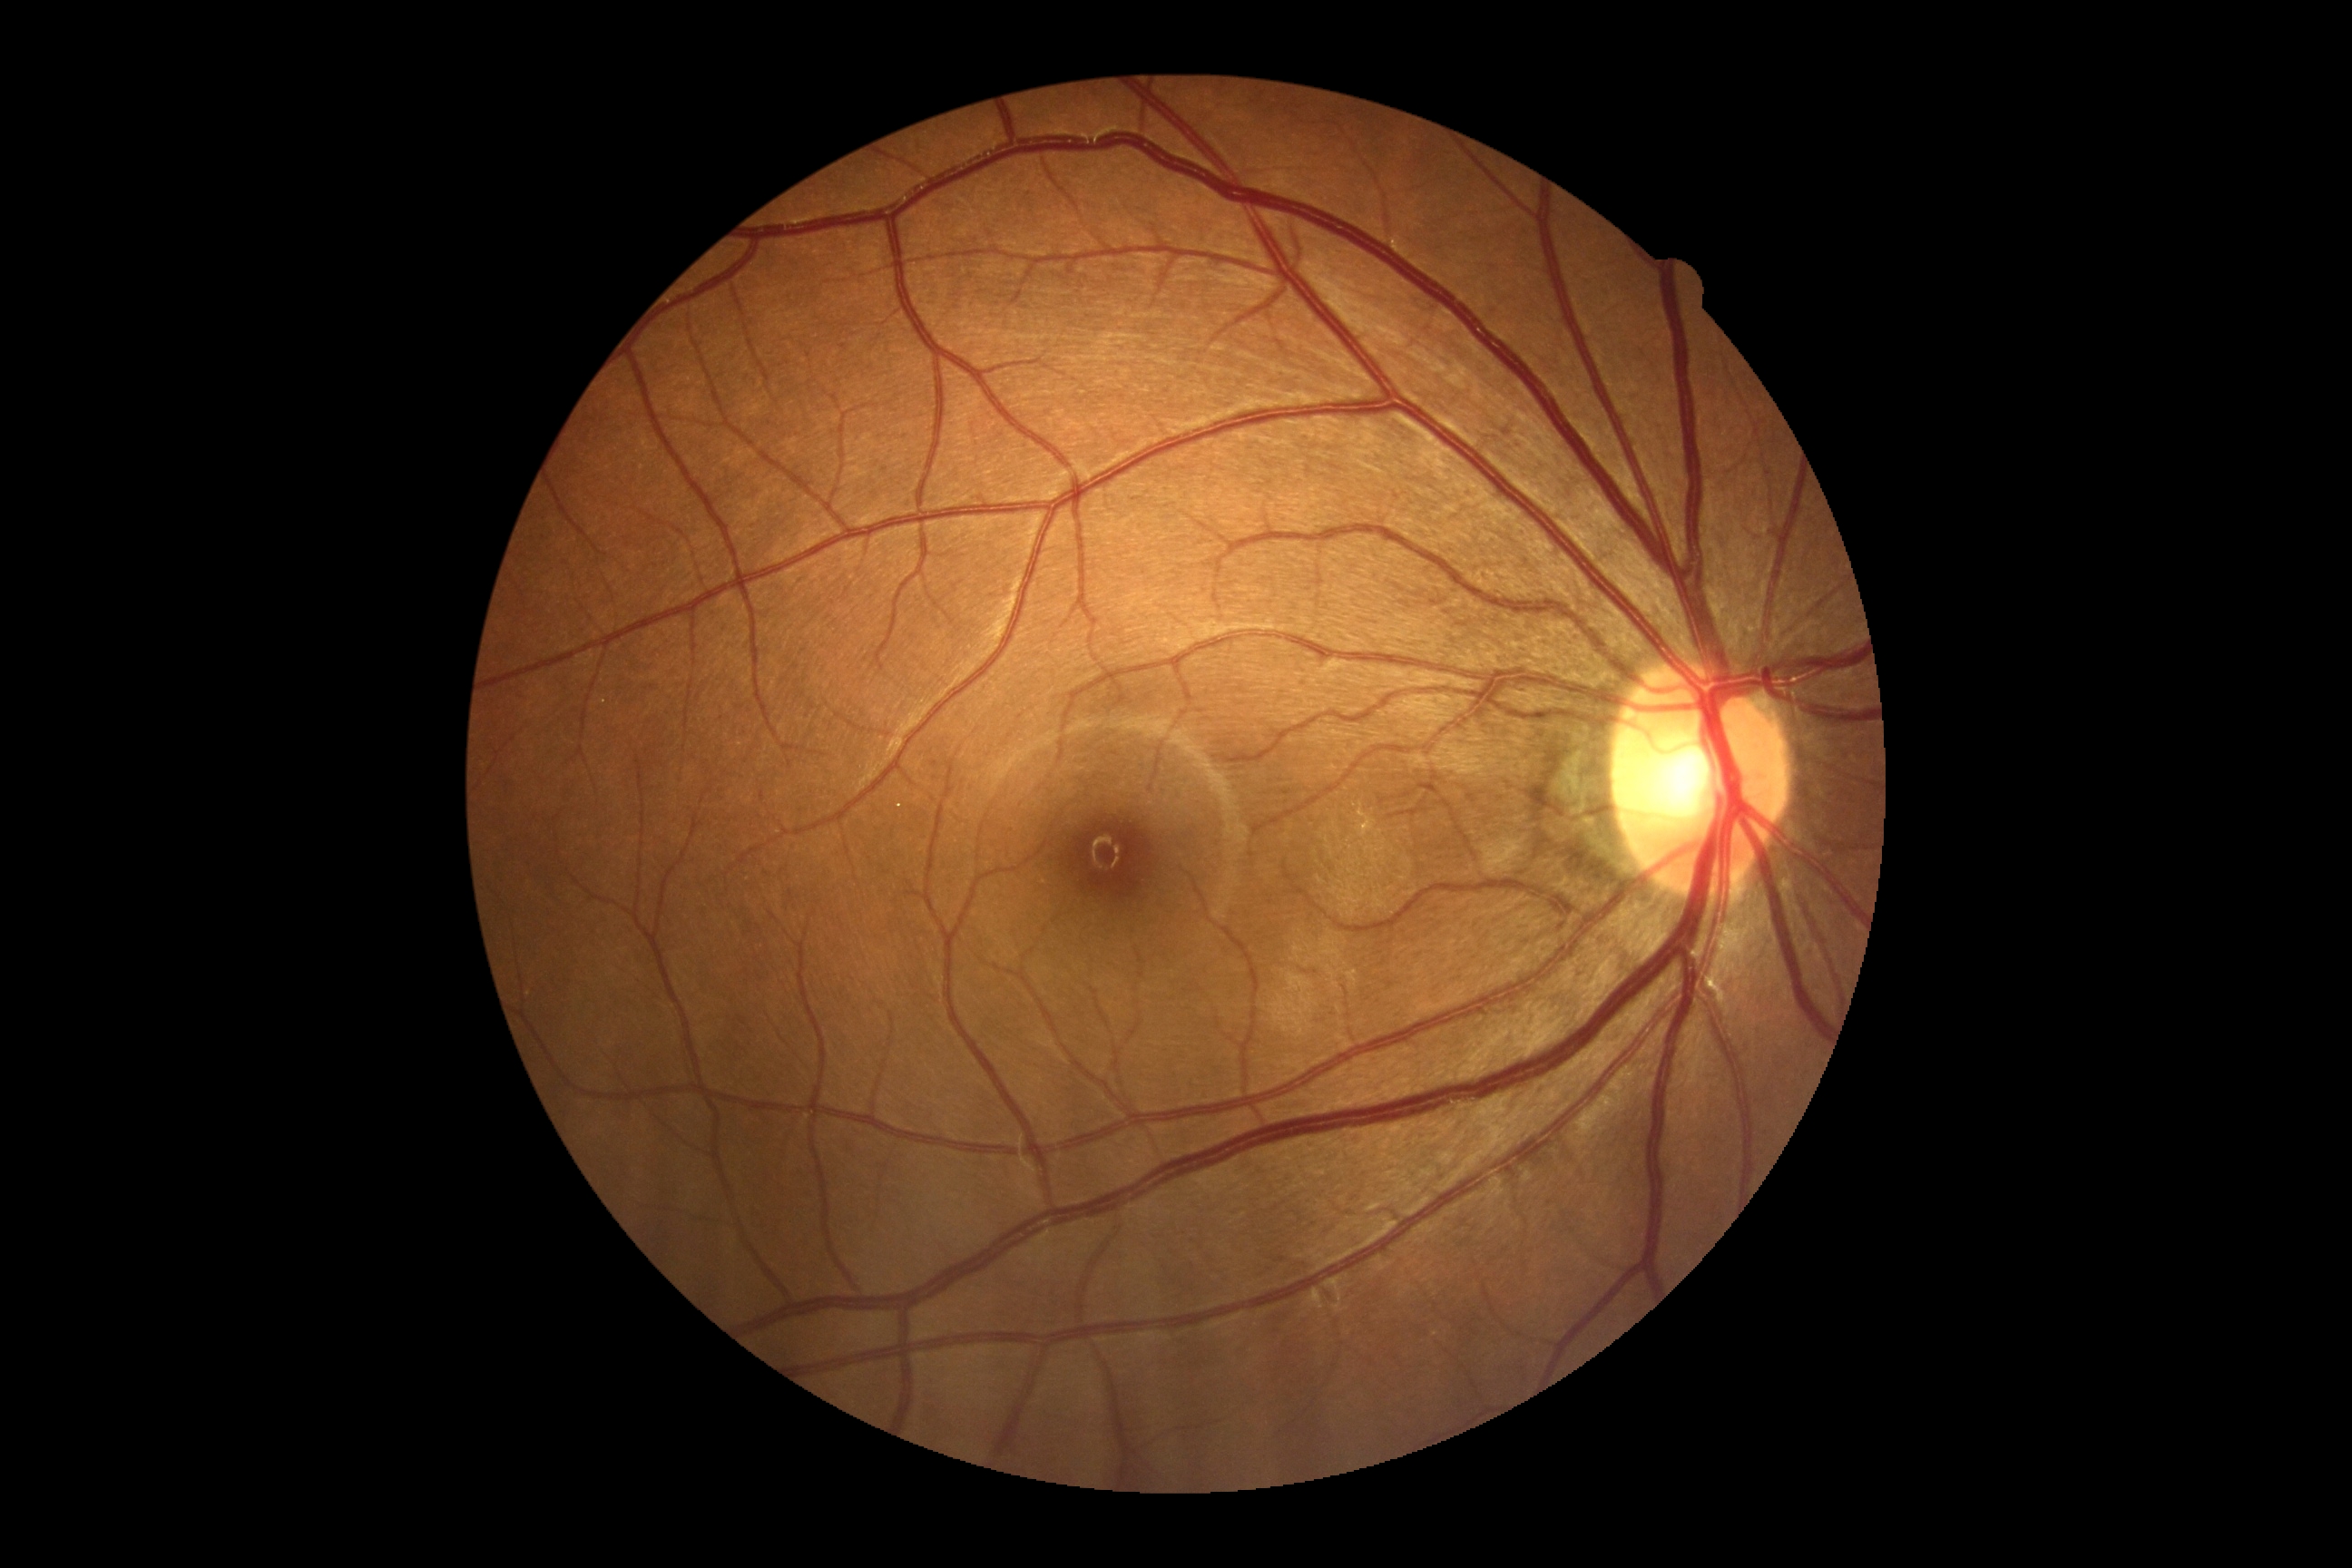 DR = 0.